1932x1932px.
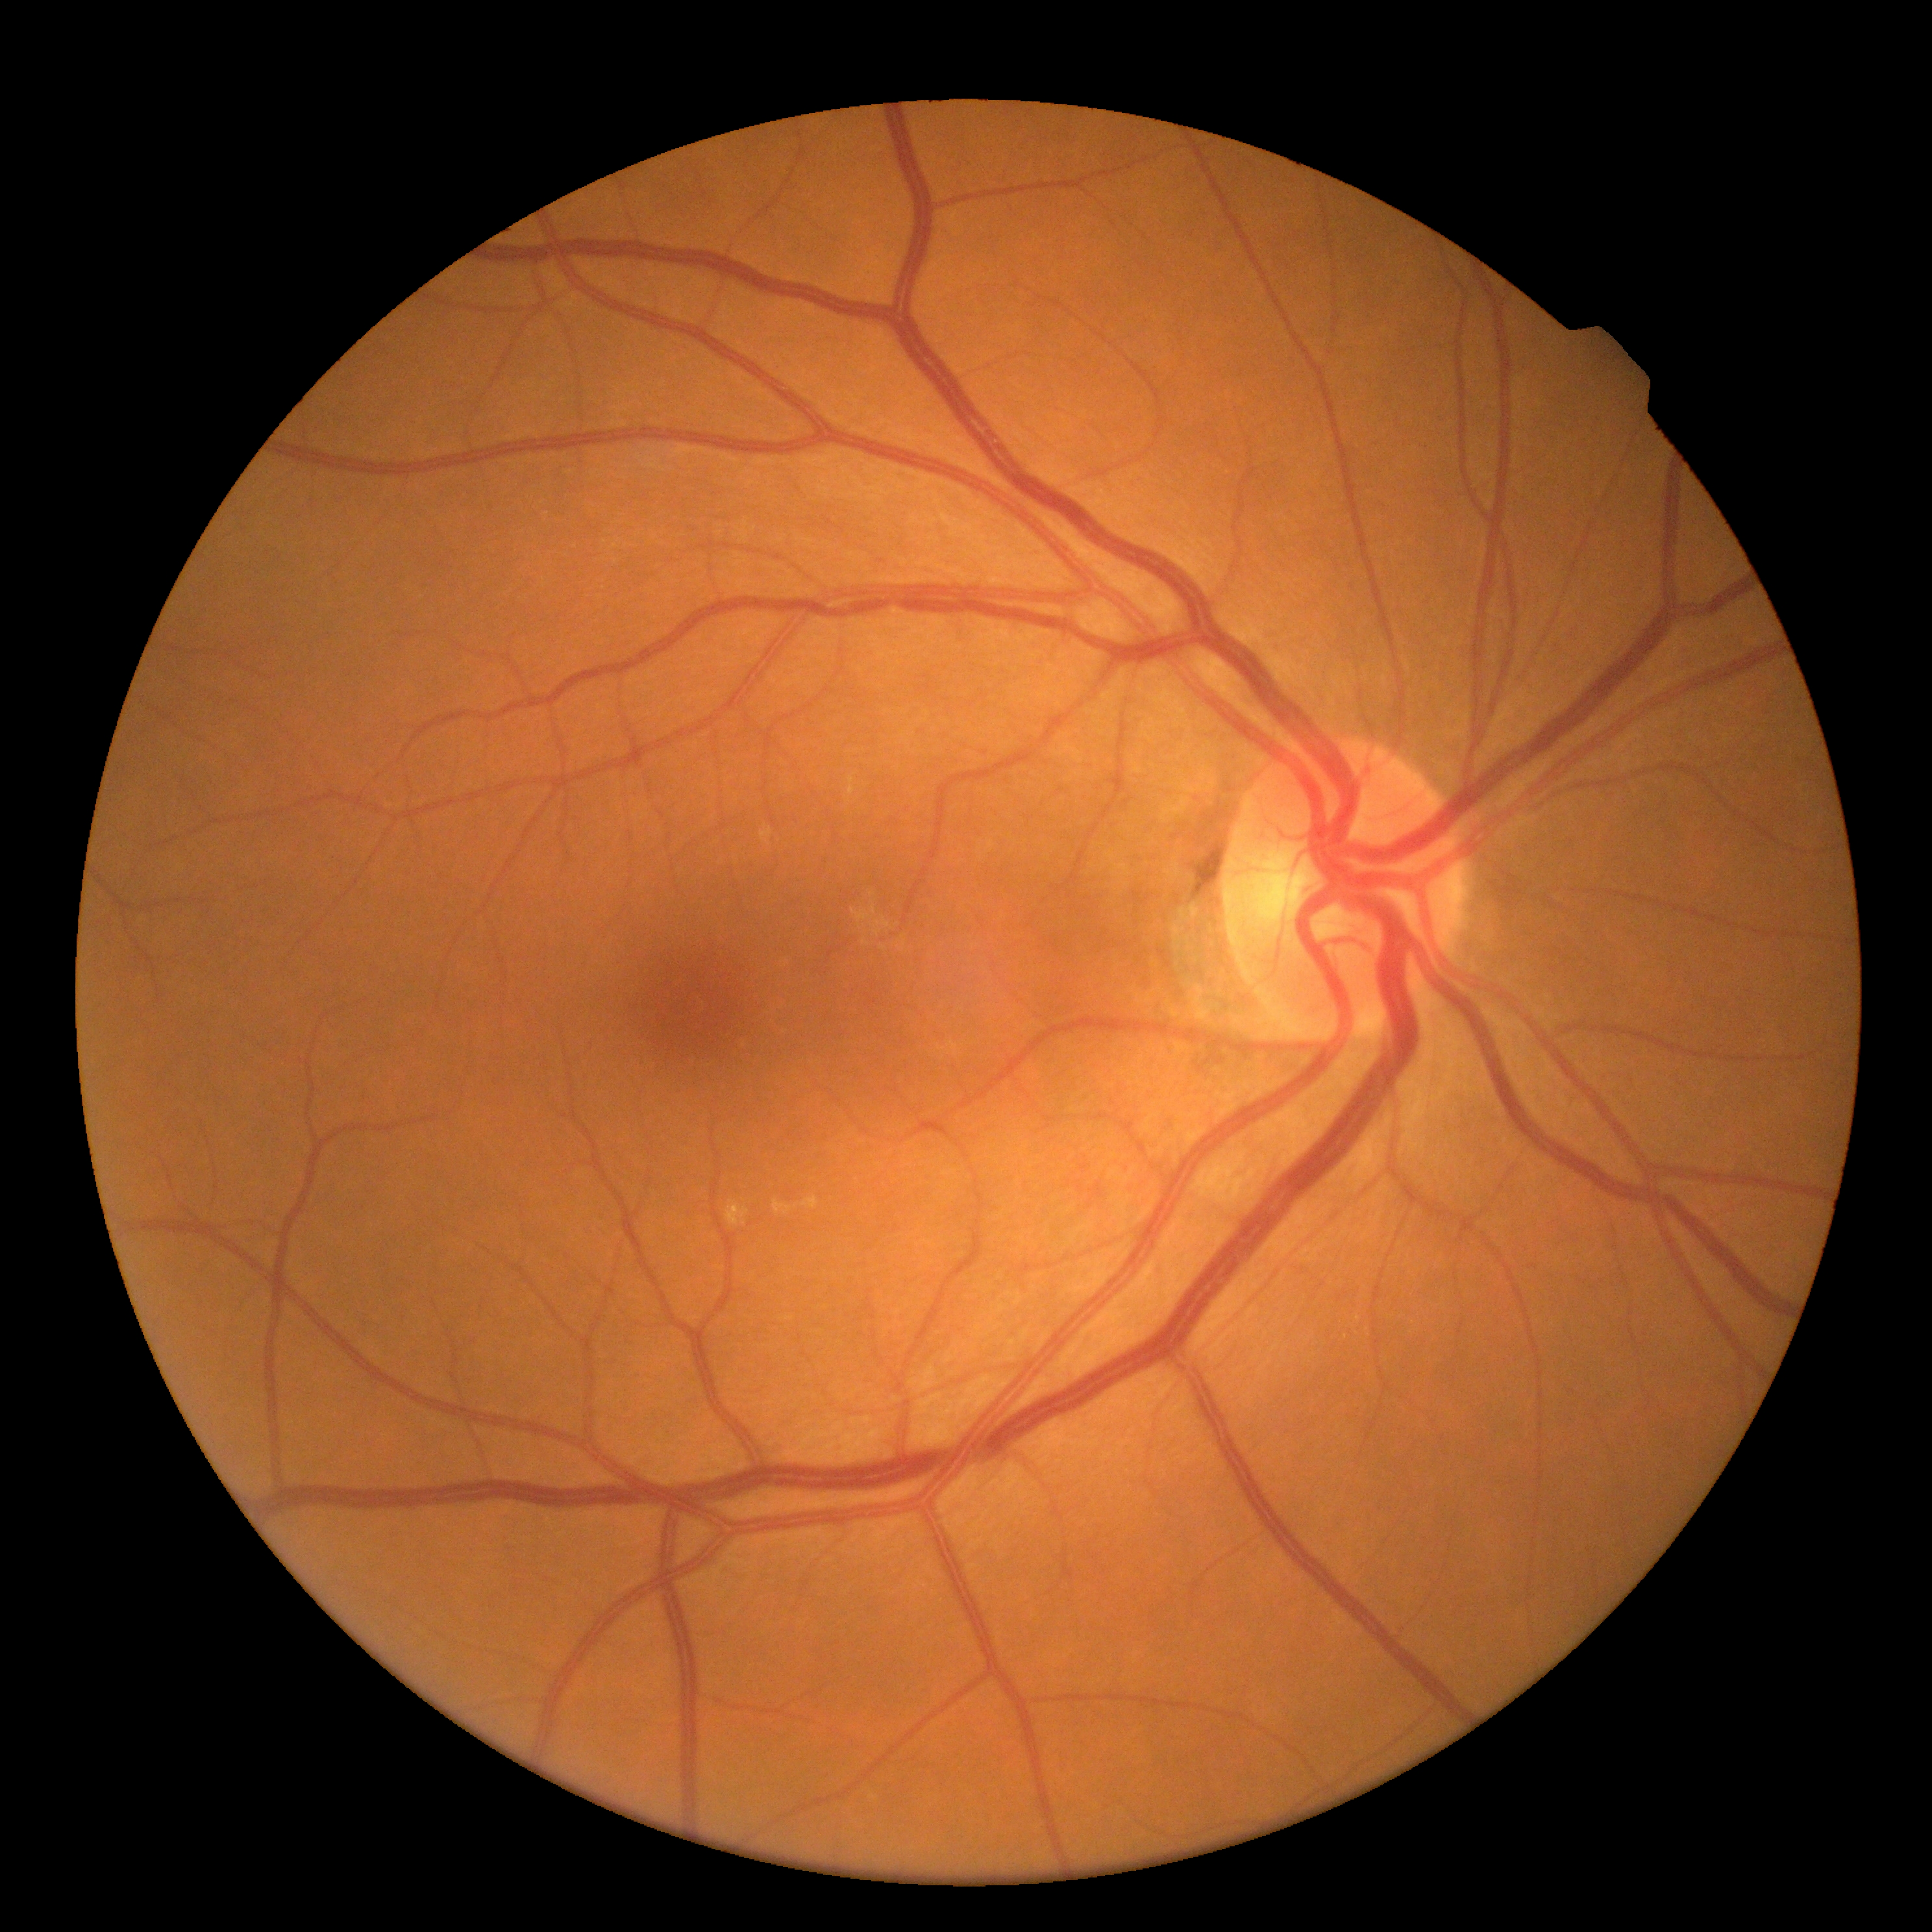
No diabetic retinal disease findings.
DR severity is grade 0 (no apparent retinopathy) — no visible signs of diabetic retinopathy.